Wide-field fundus photograph of an infant.
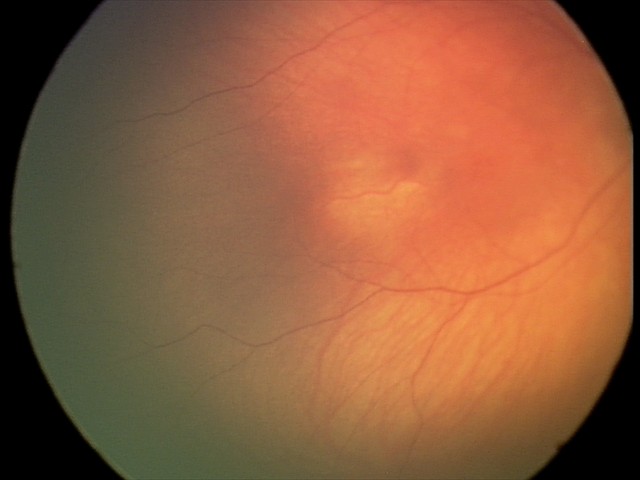
Impression = physiological